1932x1923px; color fundus photograph — 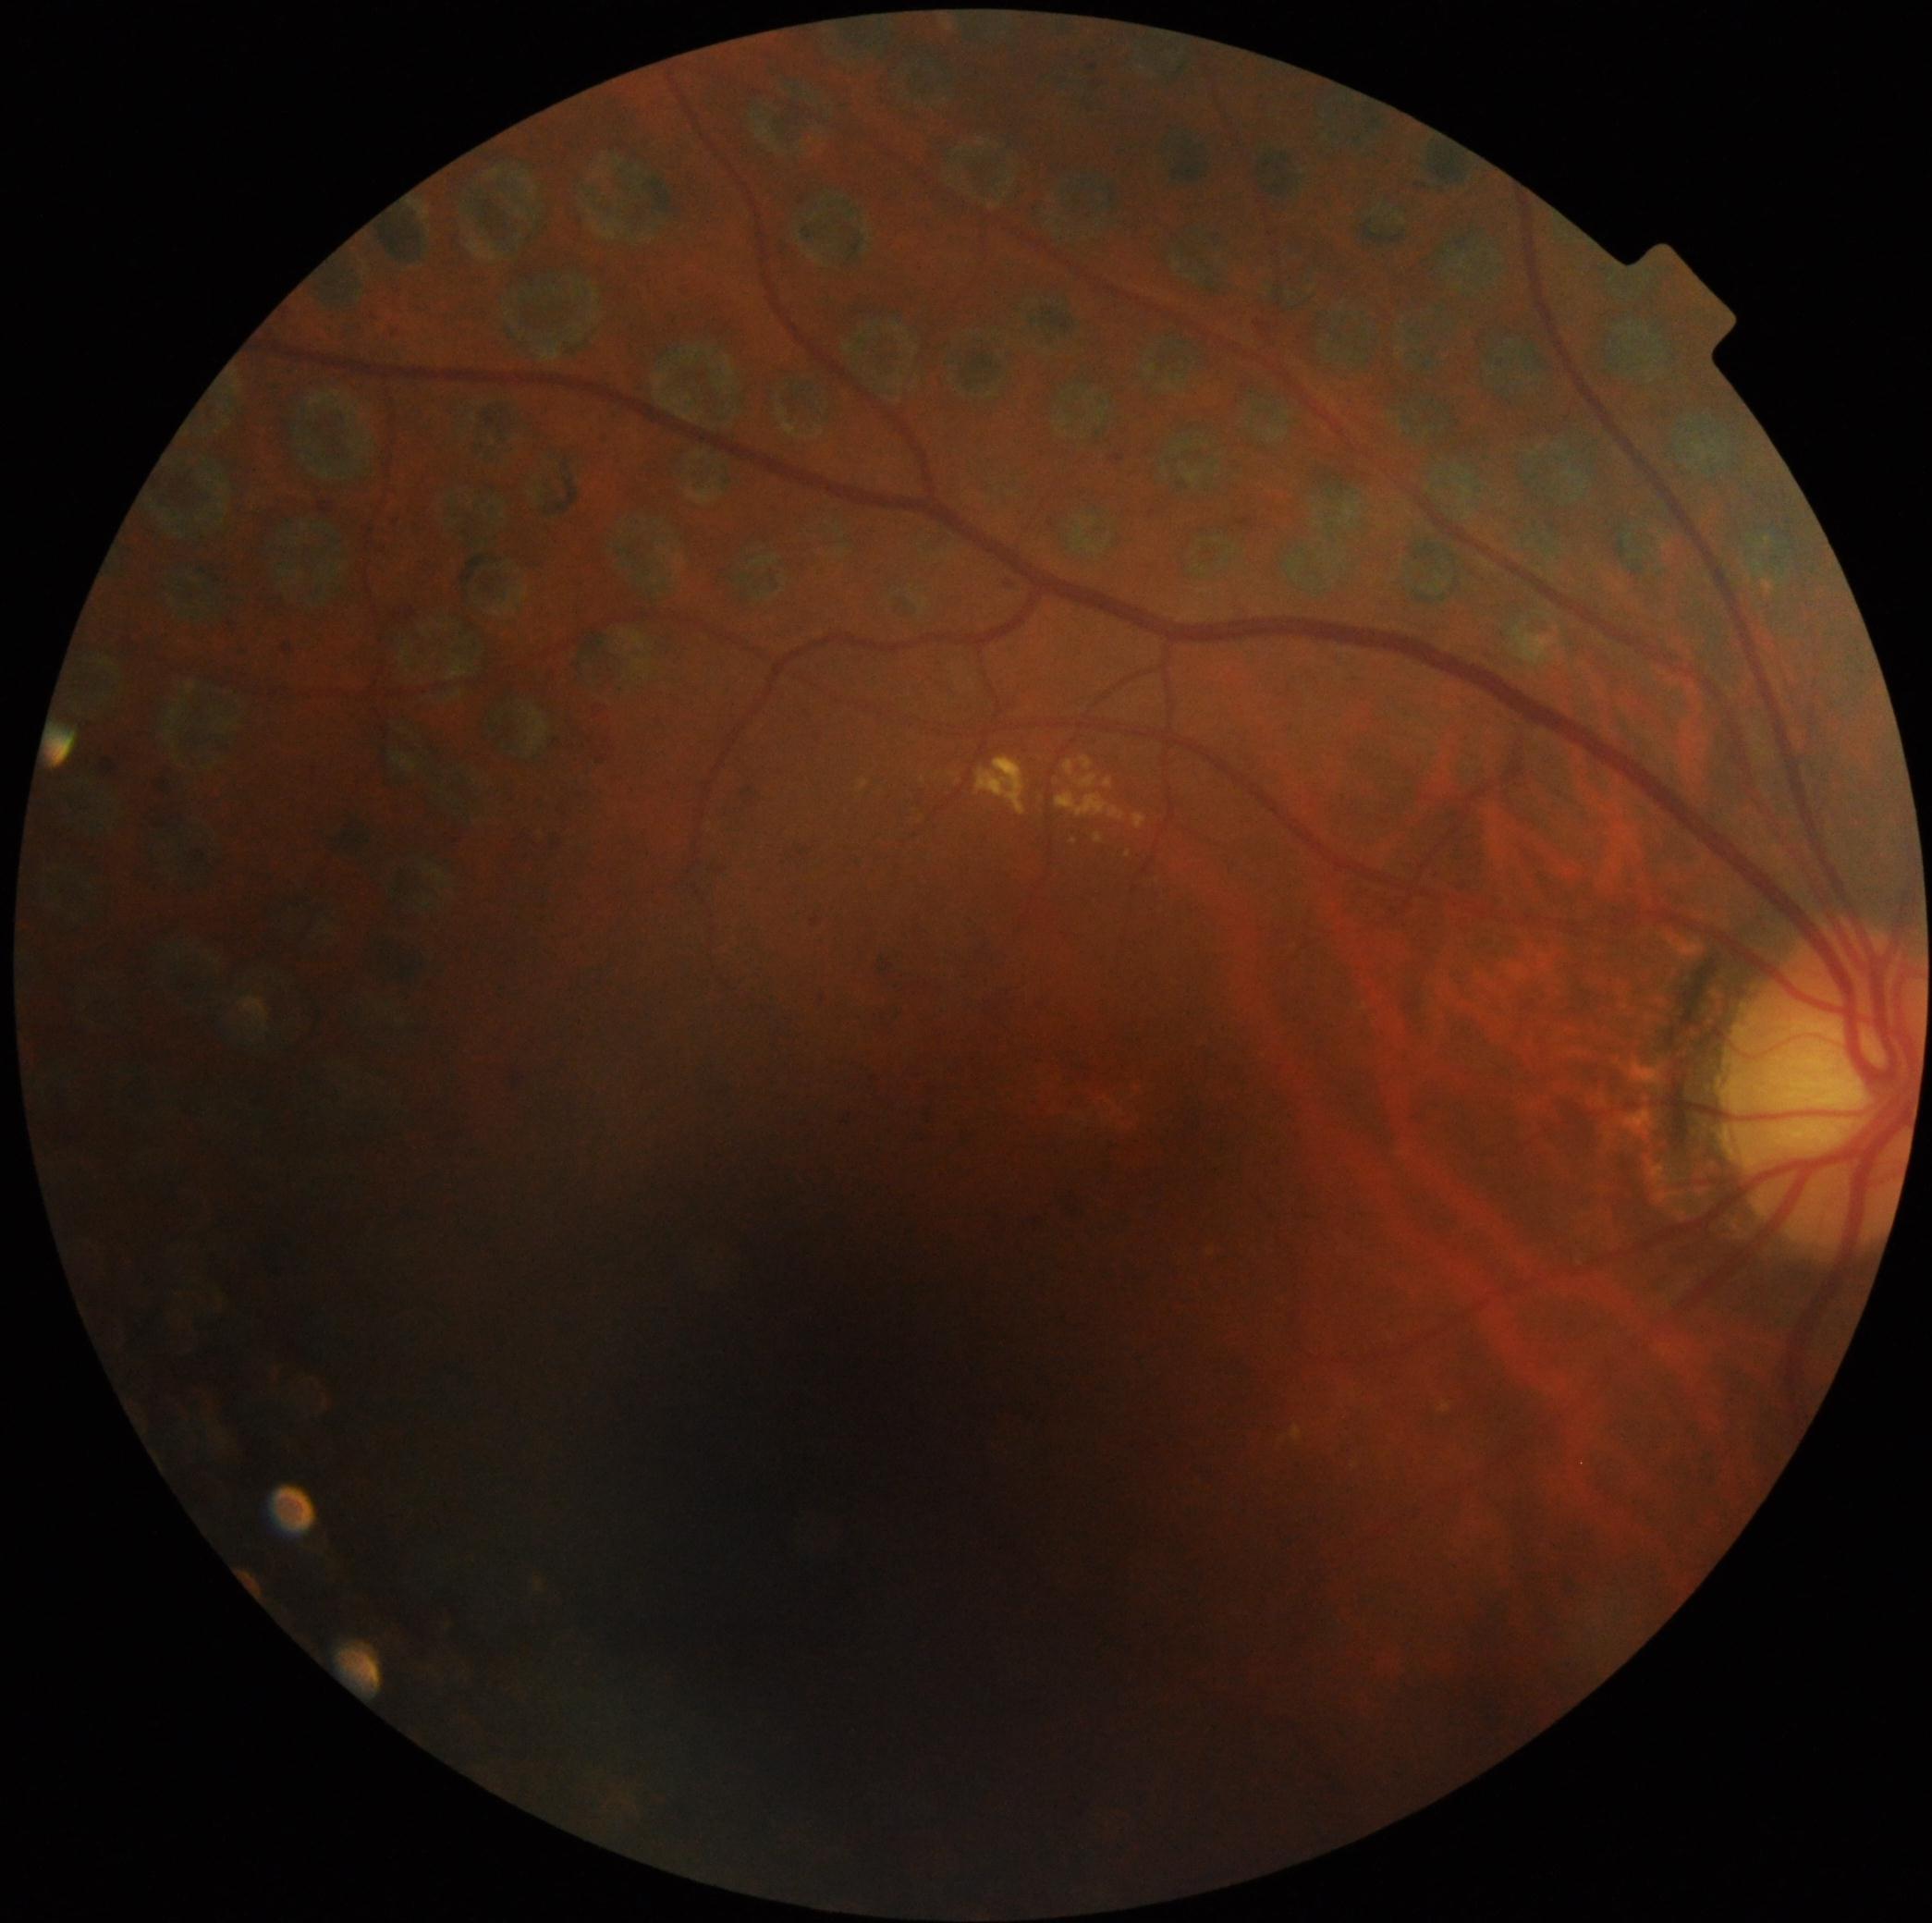
Disease class: non-proliferative diabetic retinopathy.
DR grade: 2/4.